NIDEK AFC-230 fundus camera, without pupil dilation, 45-degree field of view, retinal fundus photograph — 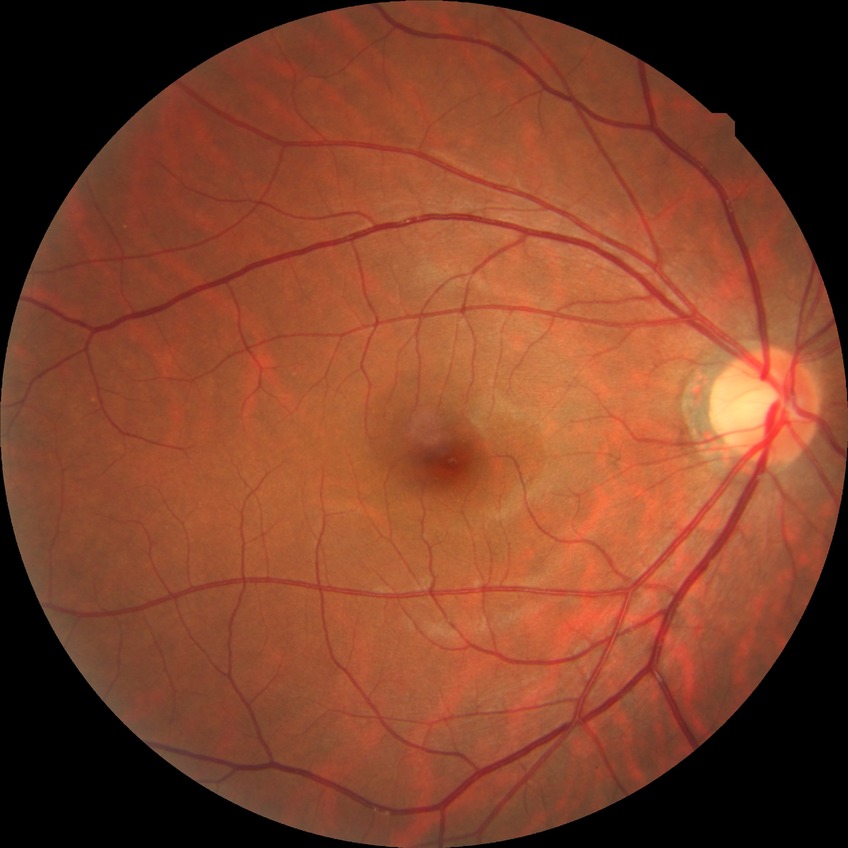

Diabetic retinopathy grade: no diabetic retinopathy.